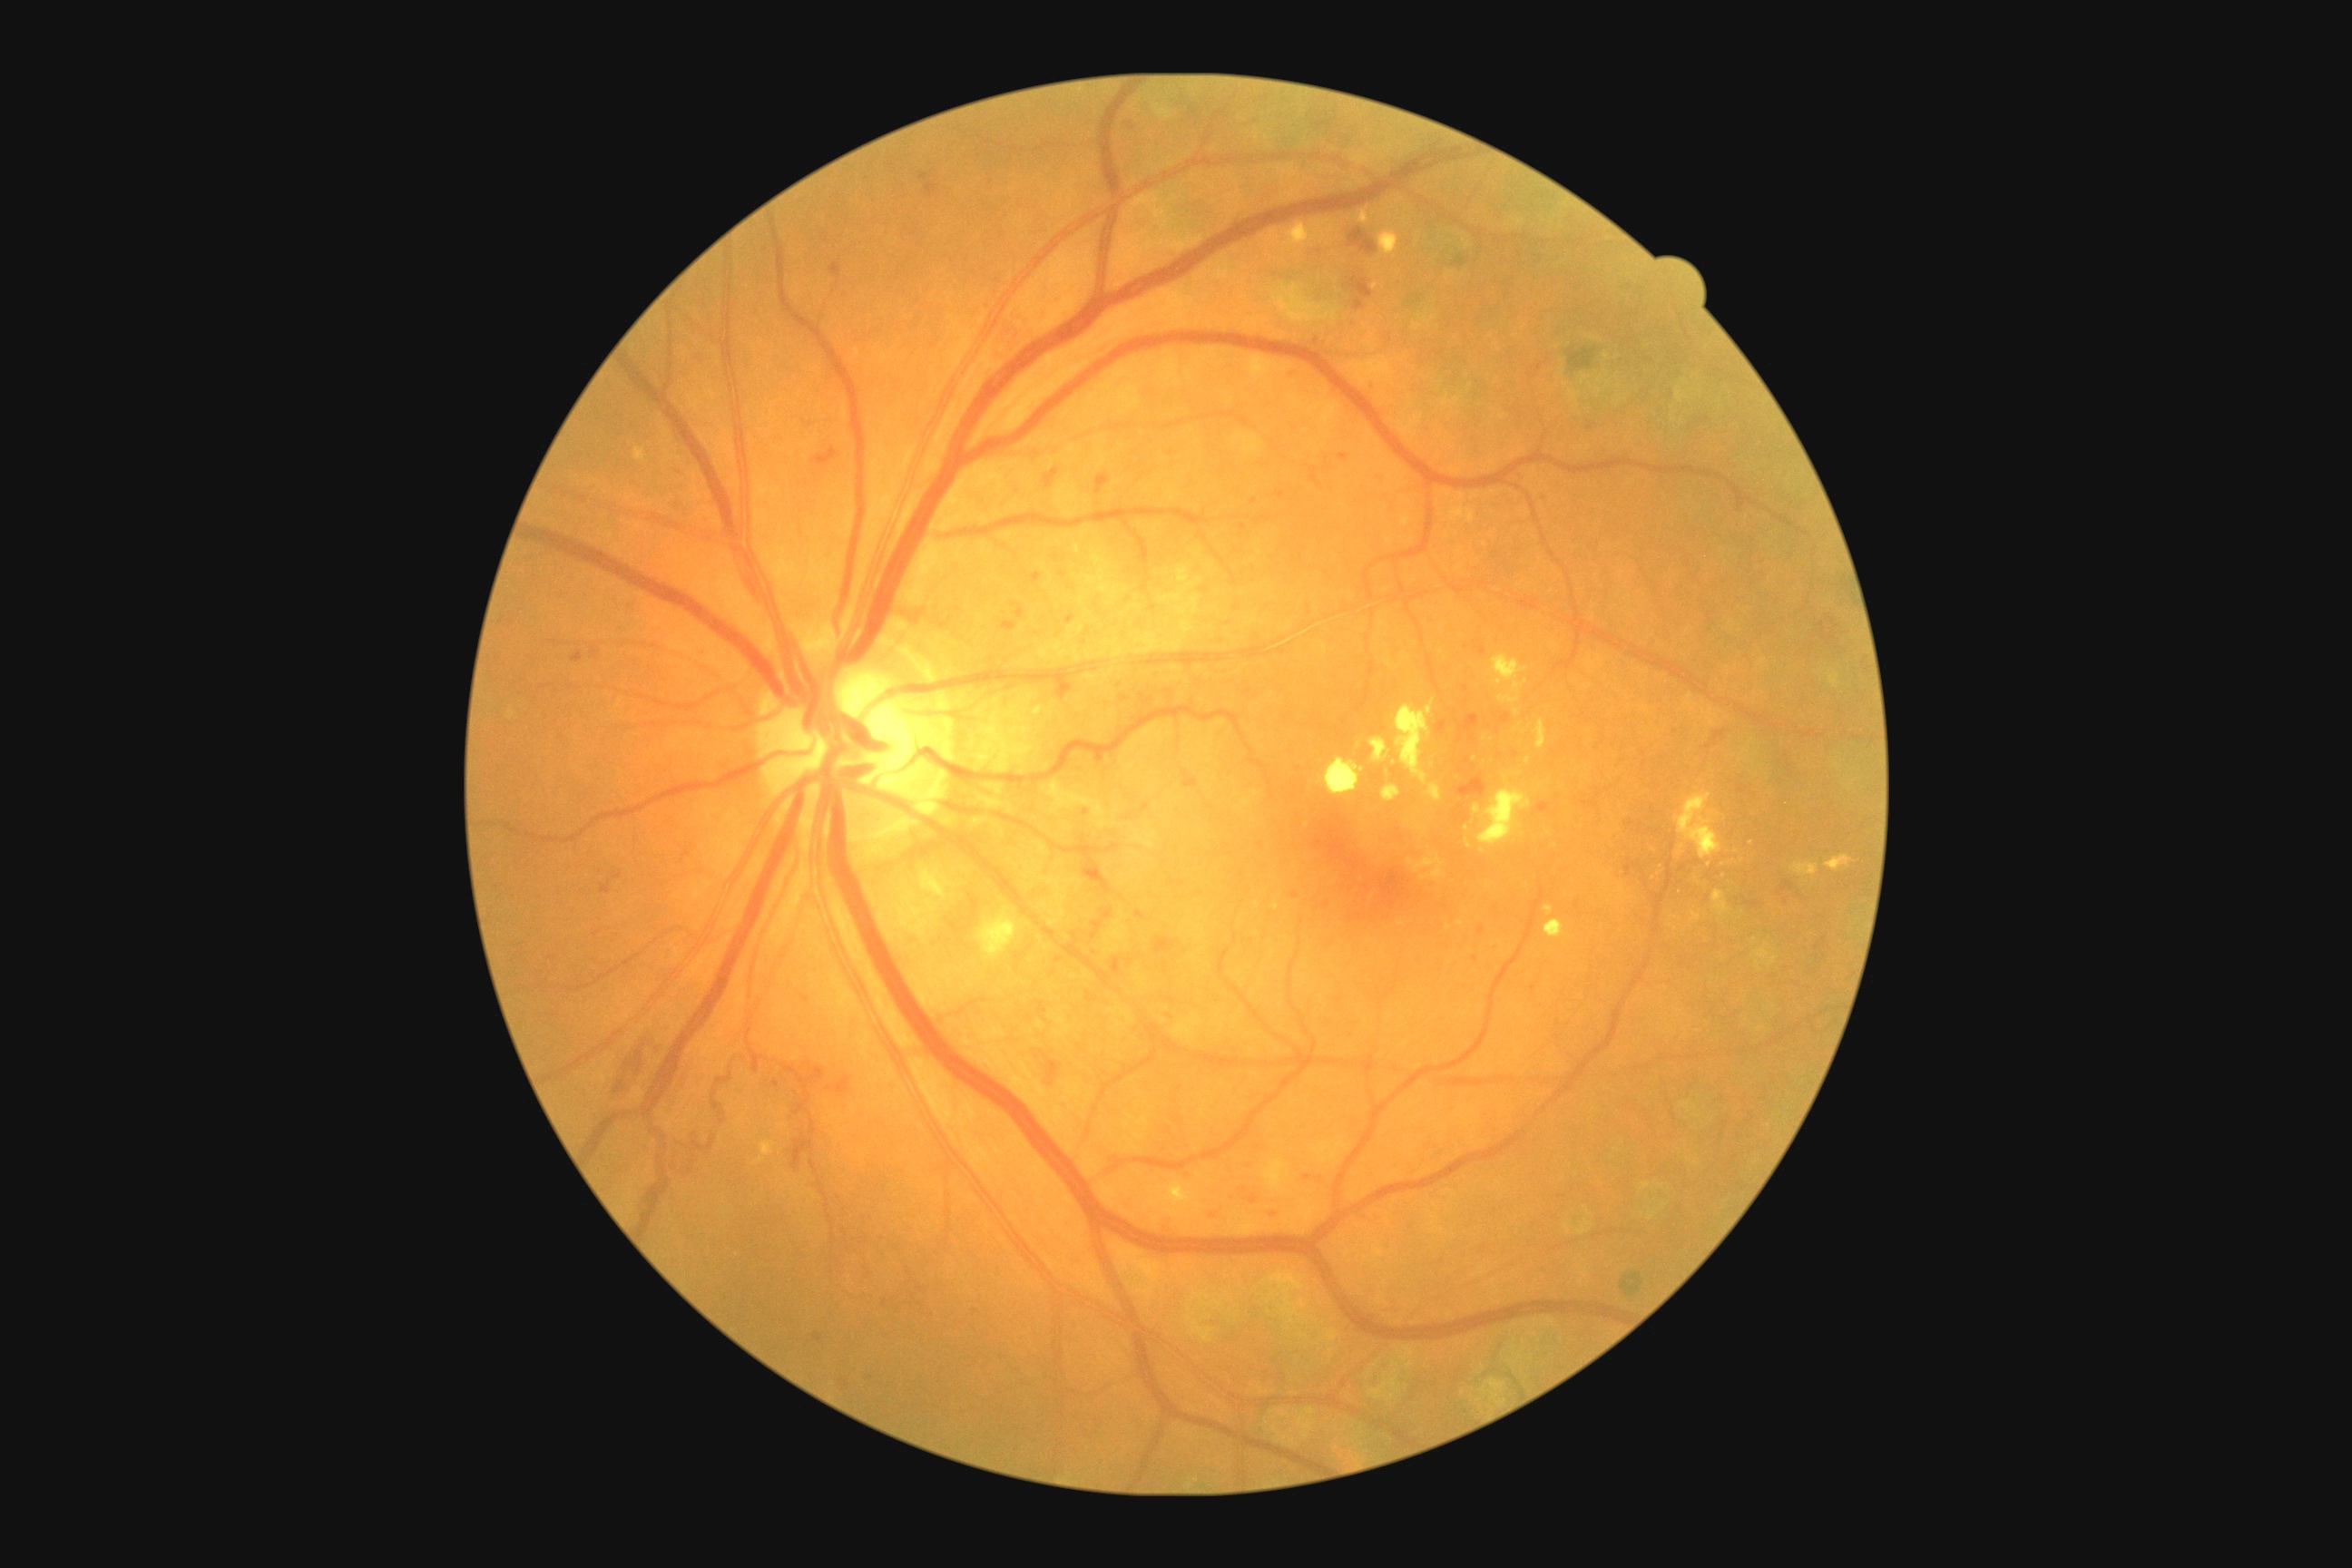
partial: true
dr_grade: 3
dr_grade_name: severe NPDR
lesions:
  he:
    - rect(1030, 573, 1043, 585)
    - rect(600, 883, 611, 896)
    - rect(1057, 681, 1073, 701)
    - rect(1286, 368, 1302, 380)
    - rect(812, 449, 838, 467)
    - rect(1338, 453, 1349, 460)
    - rect(1037, 1001, 1048, 1015)
    - rect(1224, 1164, 1237, 1179)
    - rect(667, 495, 698, 520)
    - rect(1081, 868, 1102, 881)
    - rect(1500, 714, 1511, 723)
    - rect(1436, 721, 1447, 734)
    - rect(607, 1034, 665, 1104)
  he_small:
    - <point>1590, 428</point>
    - <point>1467, 762</point>
    - <point>1063, 575</point>
    - <point>1516, 756</point>
    - <point>1140, 915</point>
  ex:
    - rect(974, 908, 1017, 957)
    - rect(1380, 231, 1398, 257)
    - rect(1476, 785, 1533, 847)
    - rect(1288, 222, 1311, 250)
    - rect(634, 447, 647, 462)
    - rect(1514, 723, 1524, 732)
    - rect(1426, 783, 1444, 803)
    - rect(1712, 890, 1727, 906)
    - rect(1514, 709, 1520, 718)
    - rect(1475, 805, 1482, 814)
  ex_small:
    - <point>1483, 852</point>
    - <point>1375, 286</point>
    - <point>1549, 834</point>
    - <point>1484, 763</point>
    - <point>1682, 846</point>
  ma: []
  se: []